848x848:
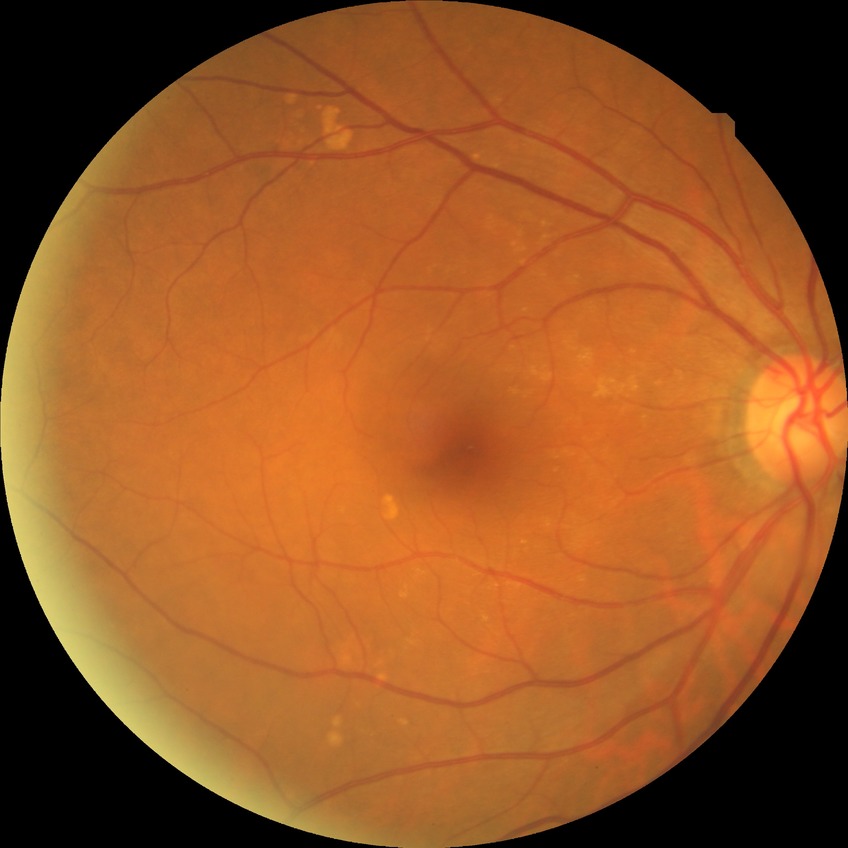
Modified Davis grading is no diabetic retinopathy.